CFP.
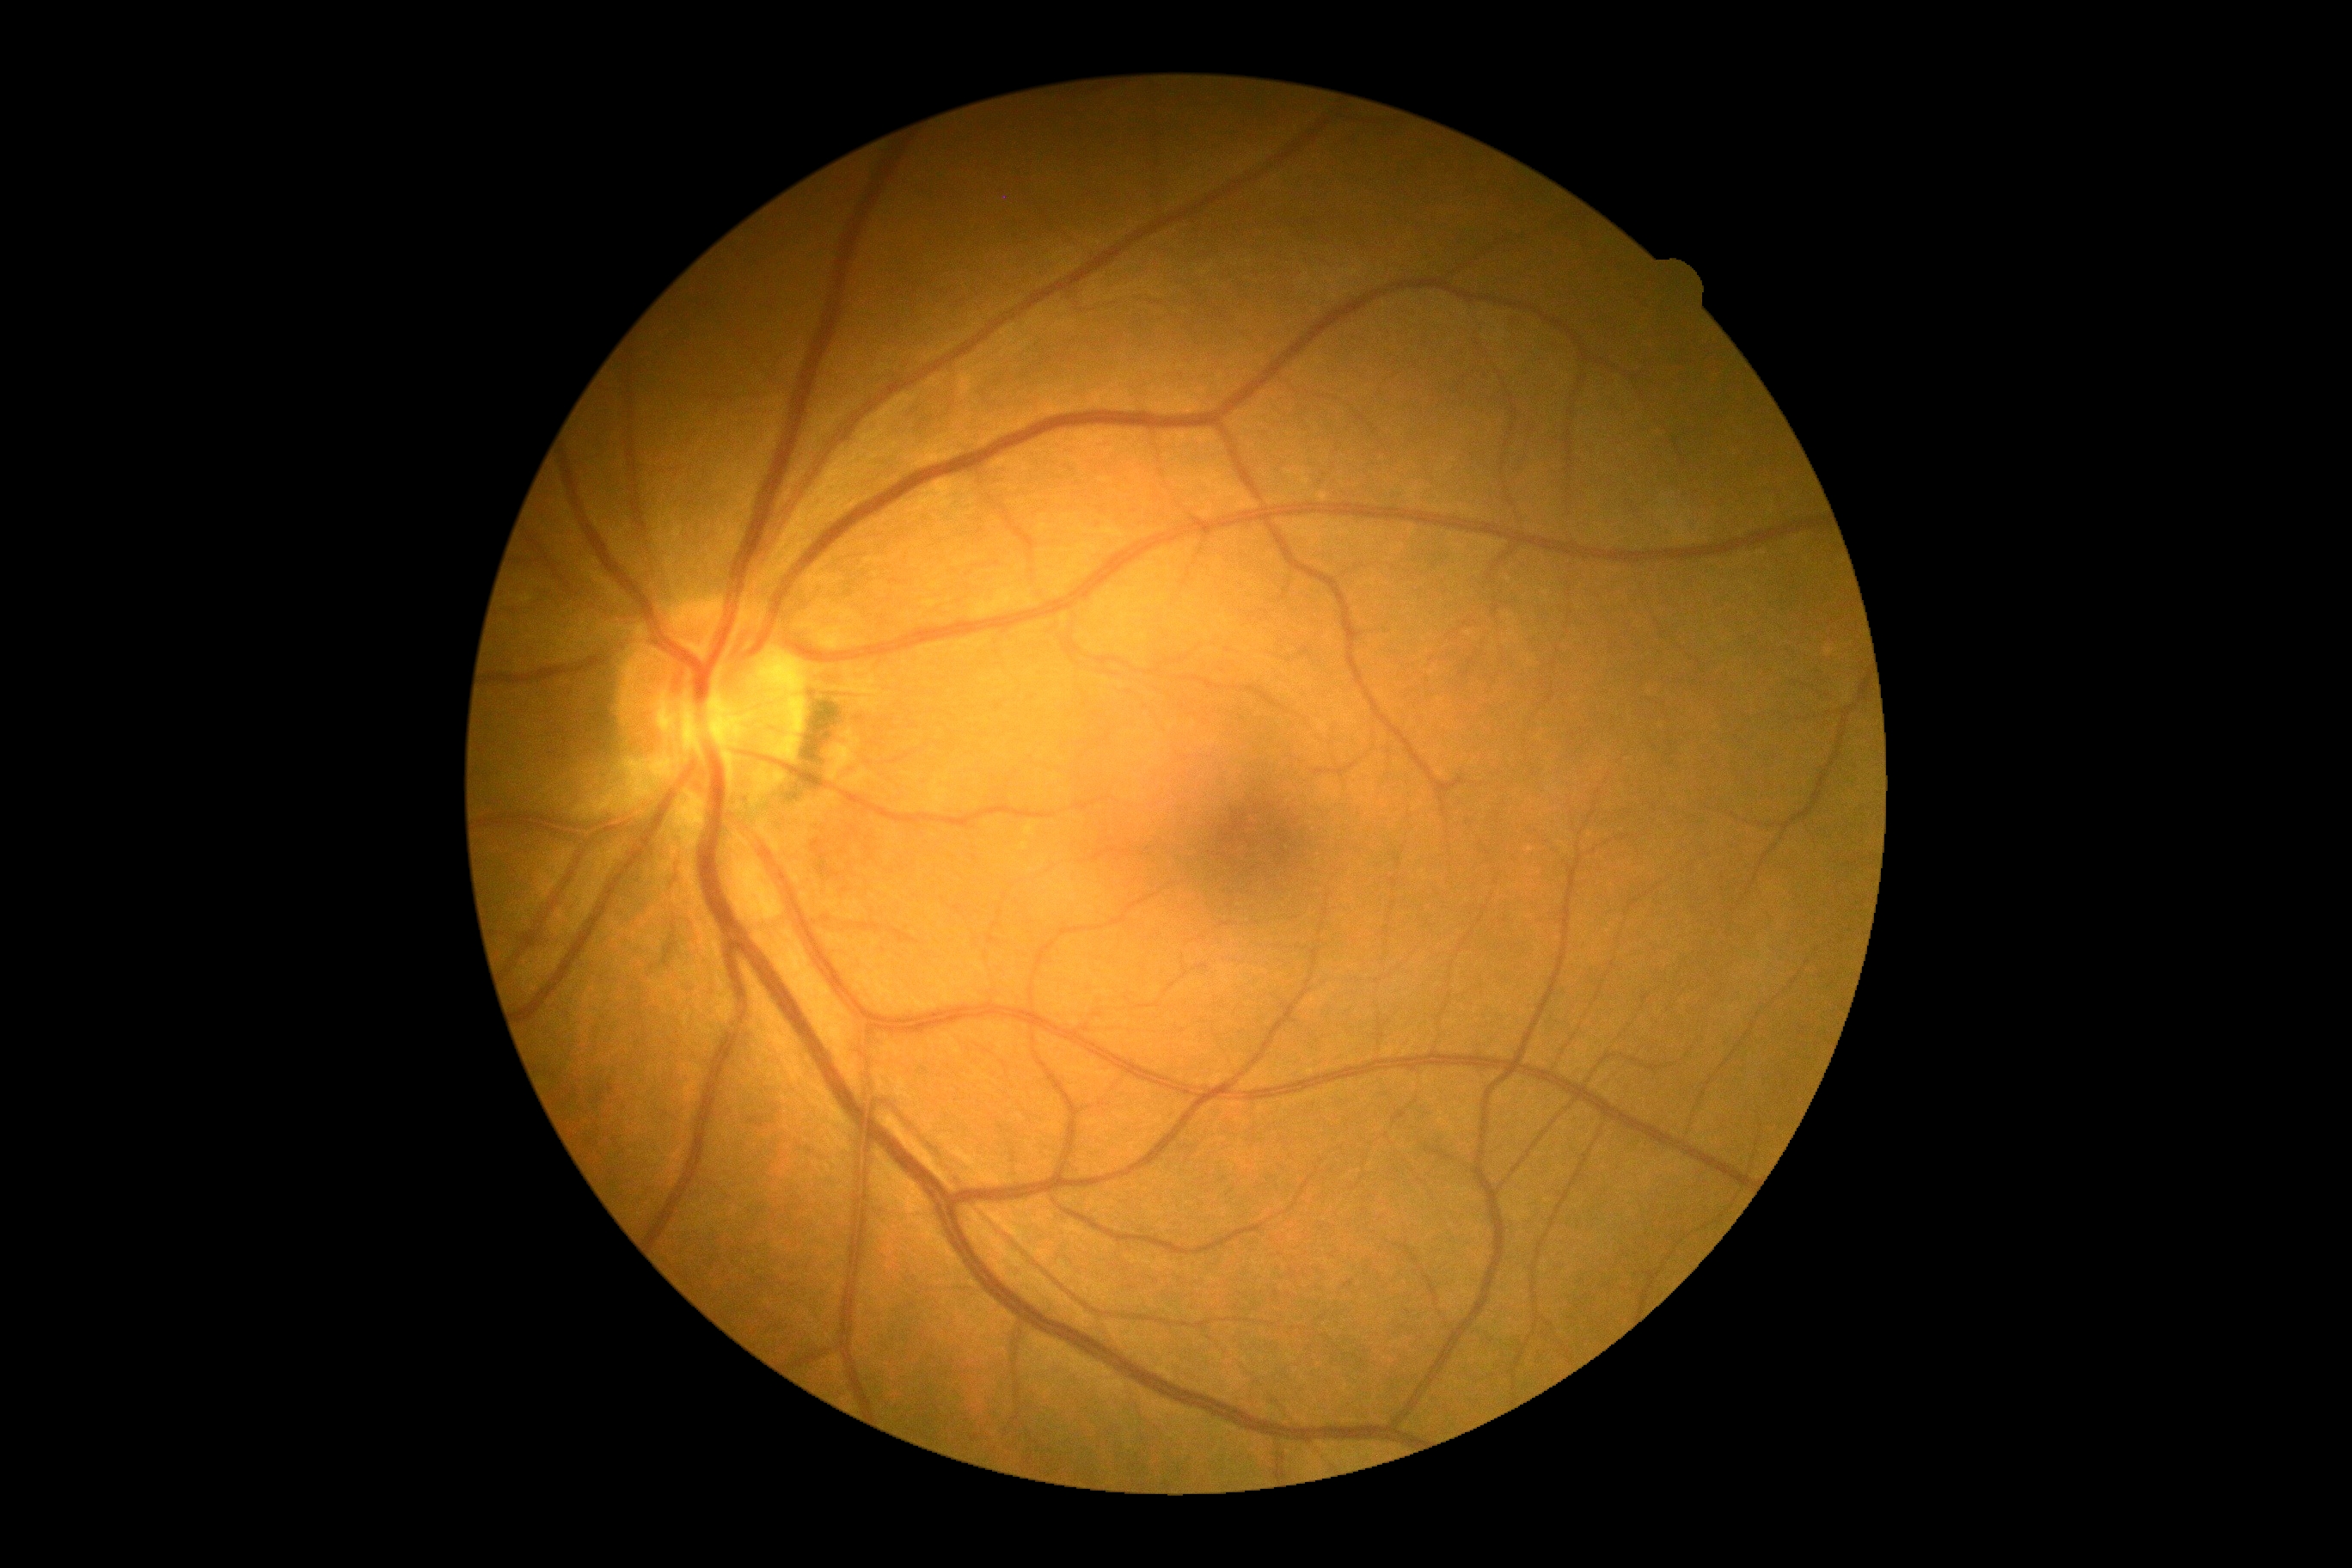 DR severity is grade 0.